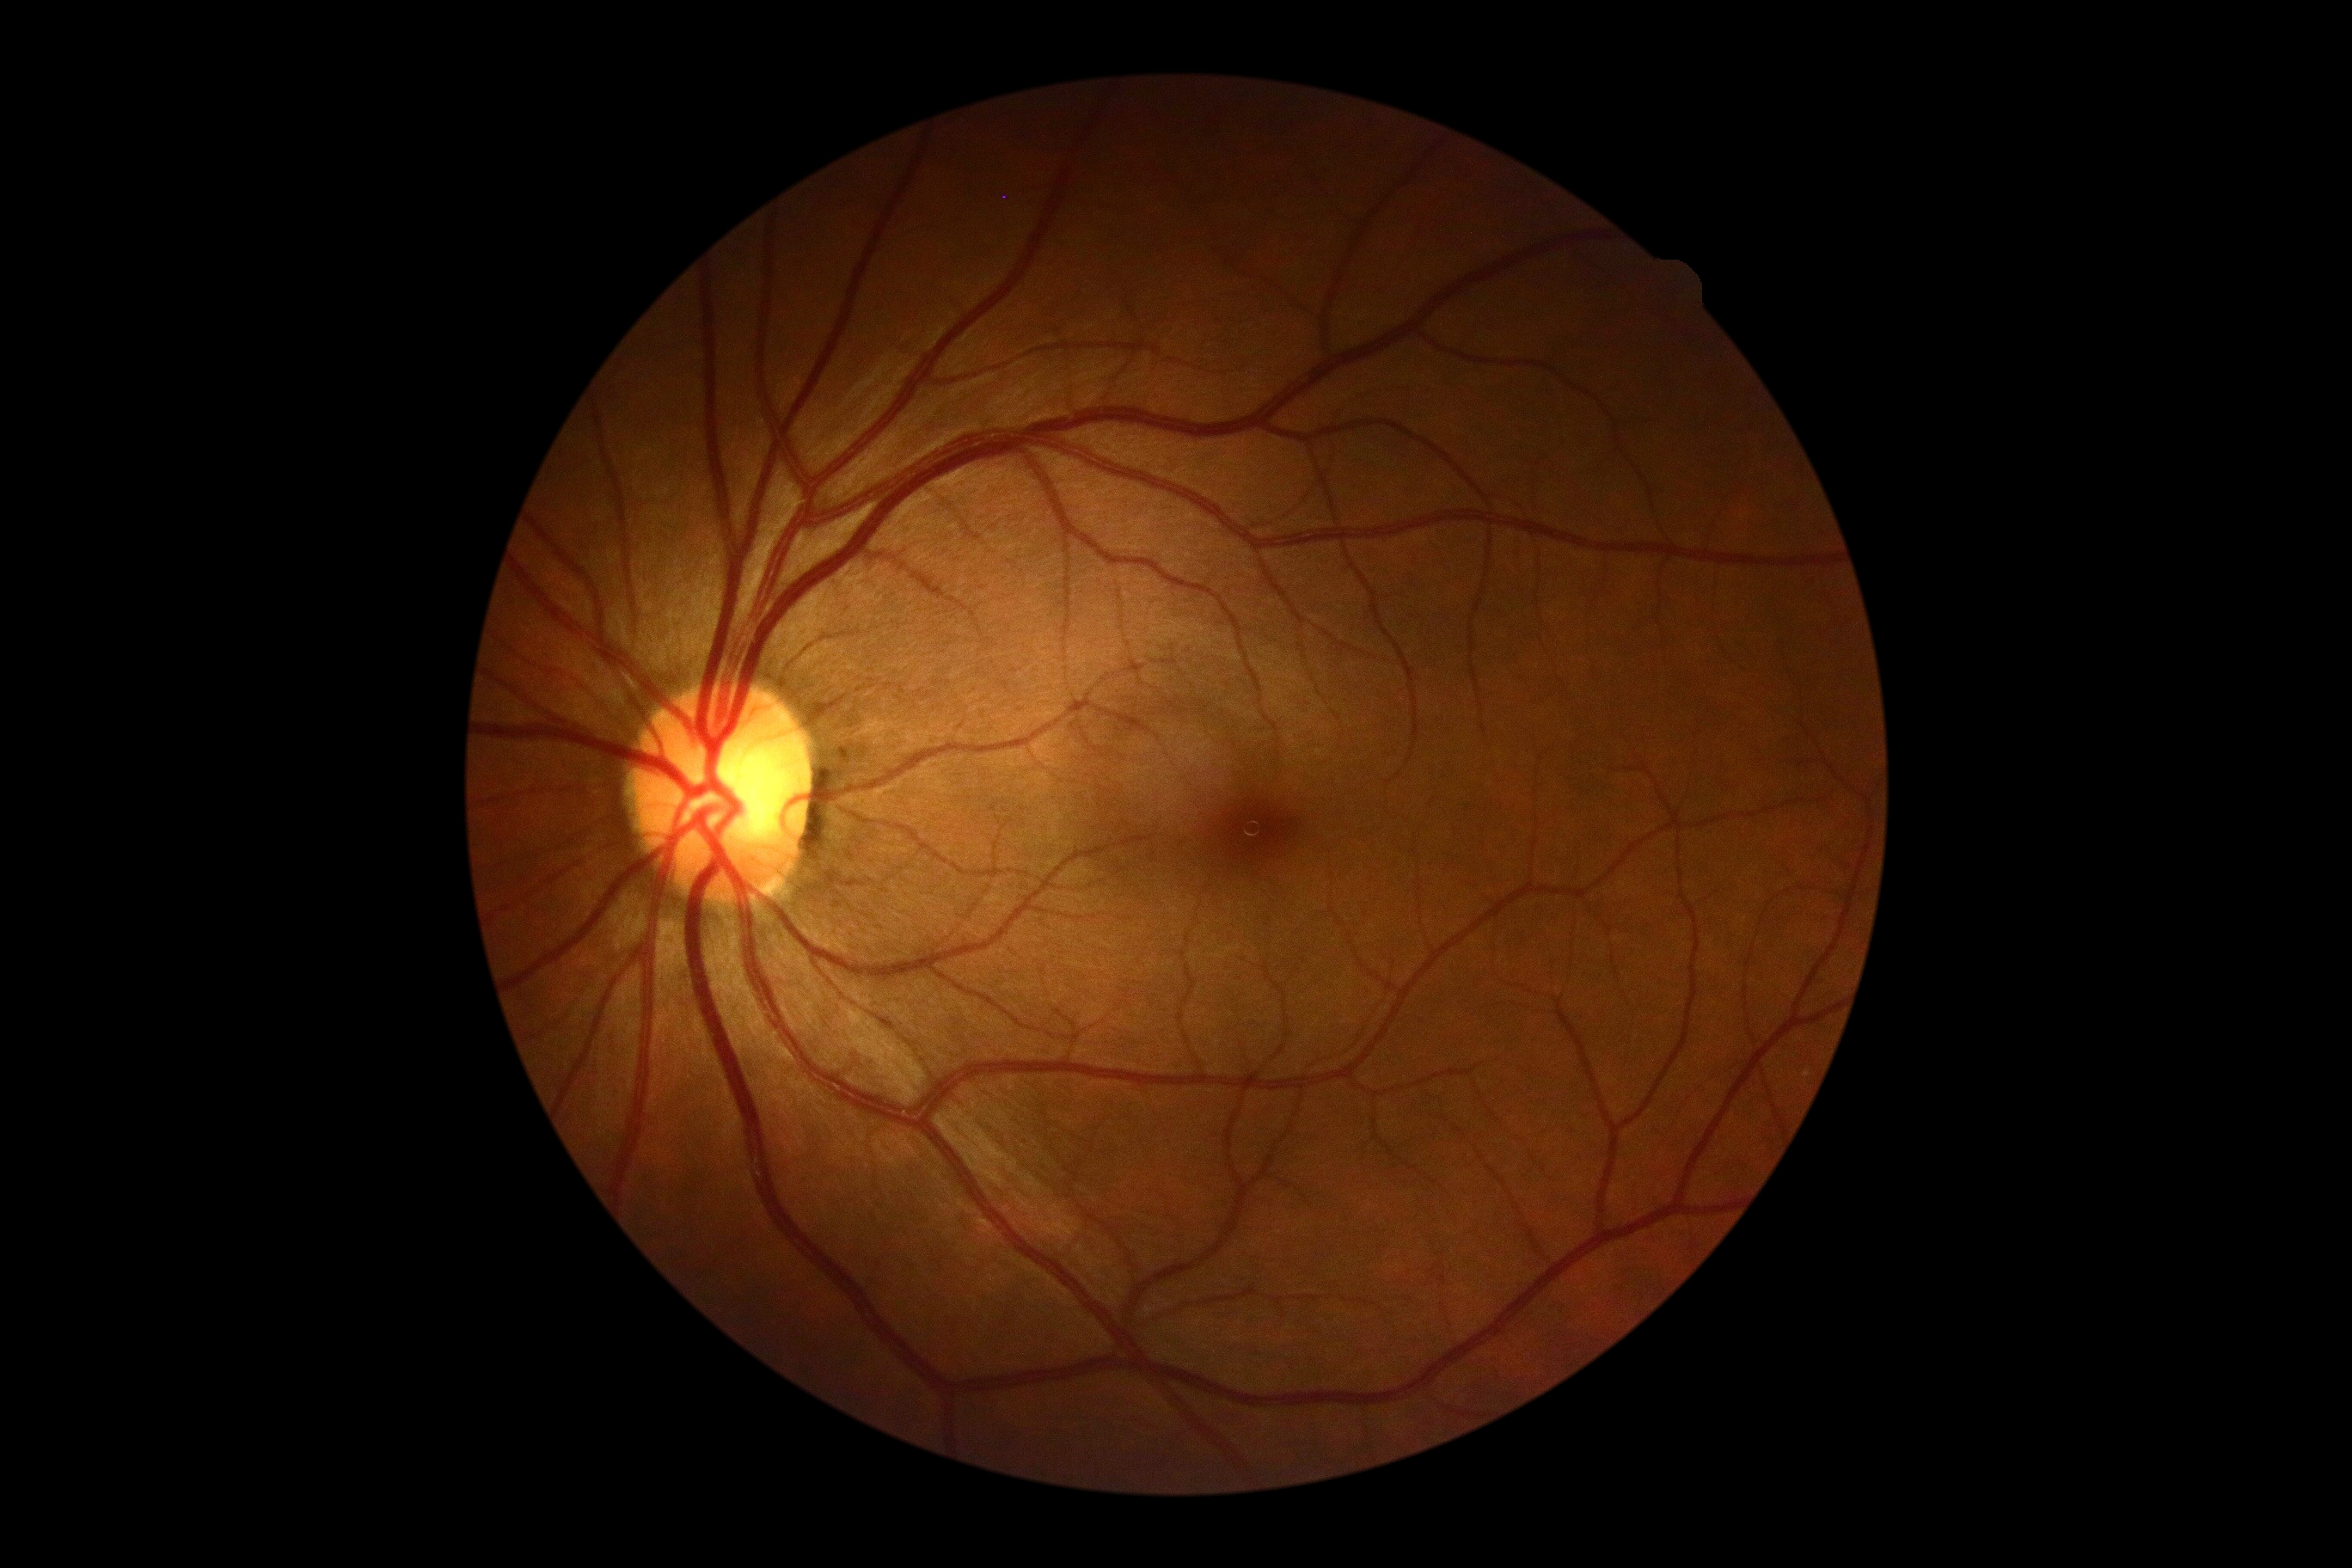
Diabetic retinopathy severity is 0/4.
No signs of diabetic retinopathy.